Captured with the Clarity RetCam 3 (130° field of view) · wide-field contact fundus photograph of an infant · 640x480px — 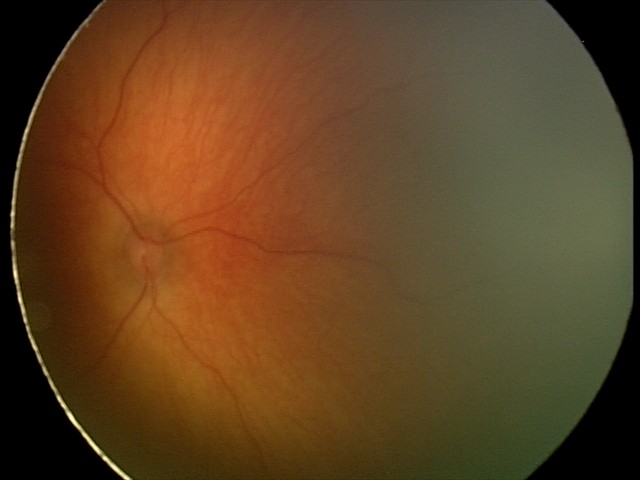 Screening examination diagnosed as physiological.